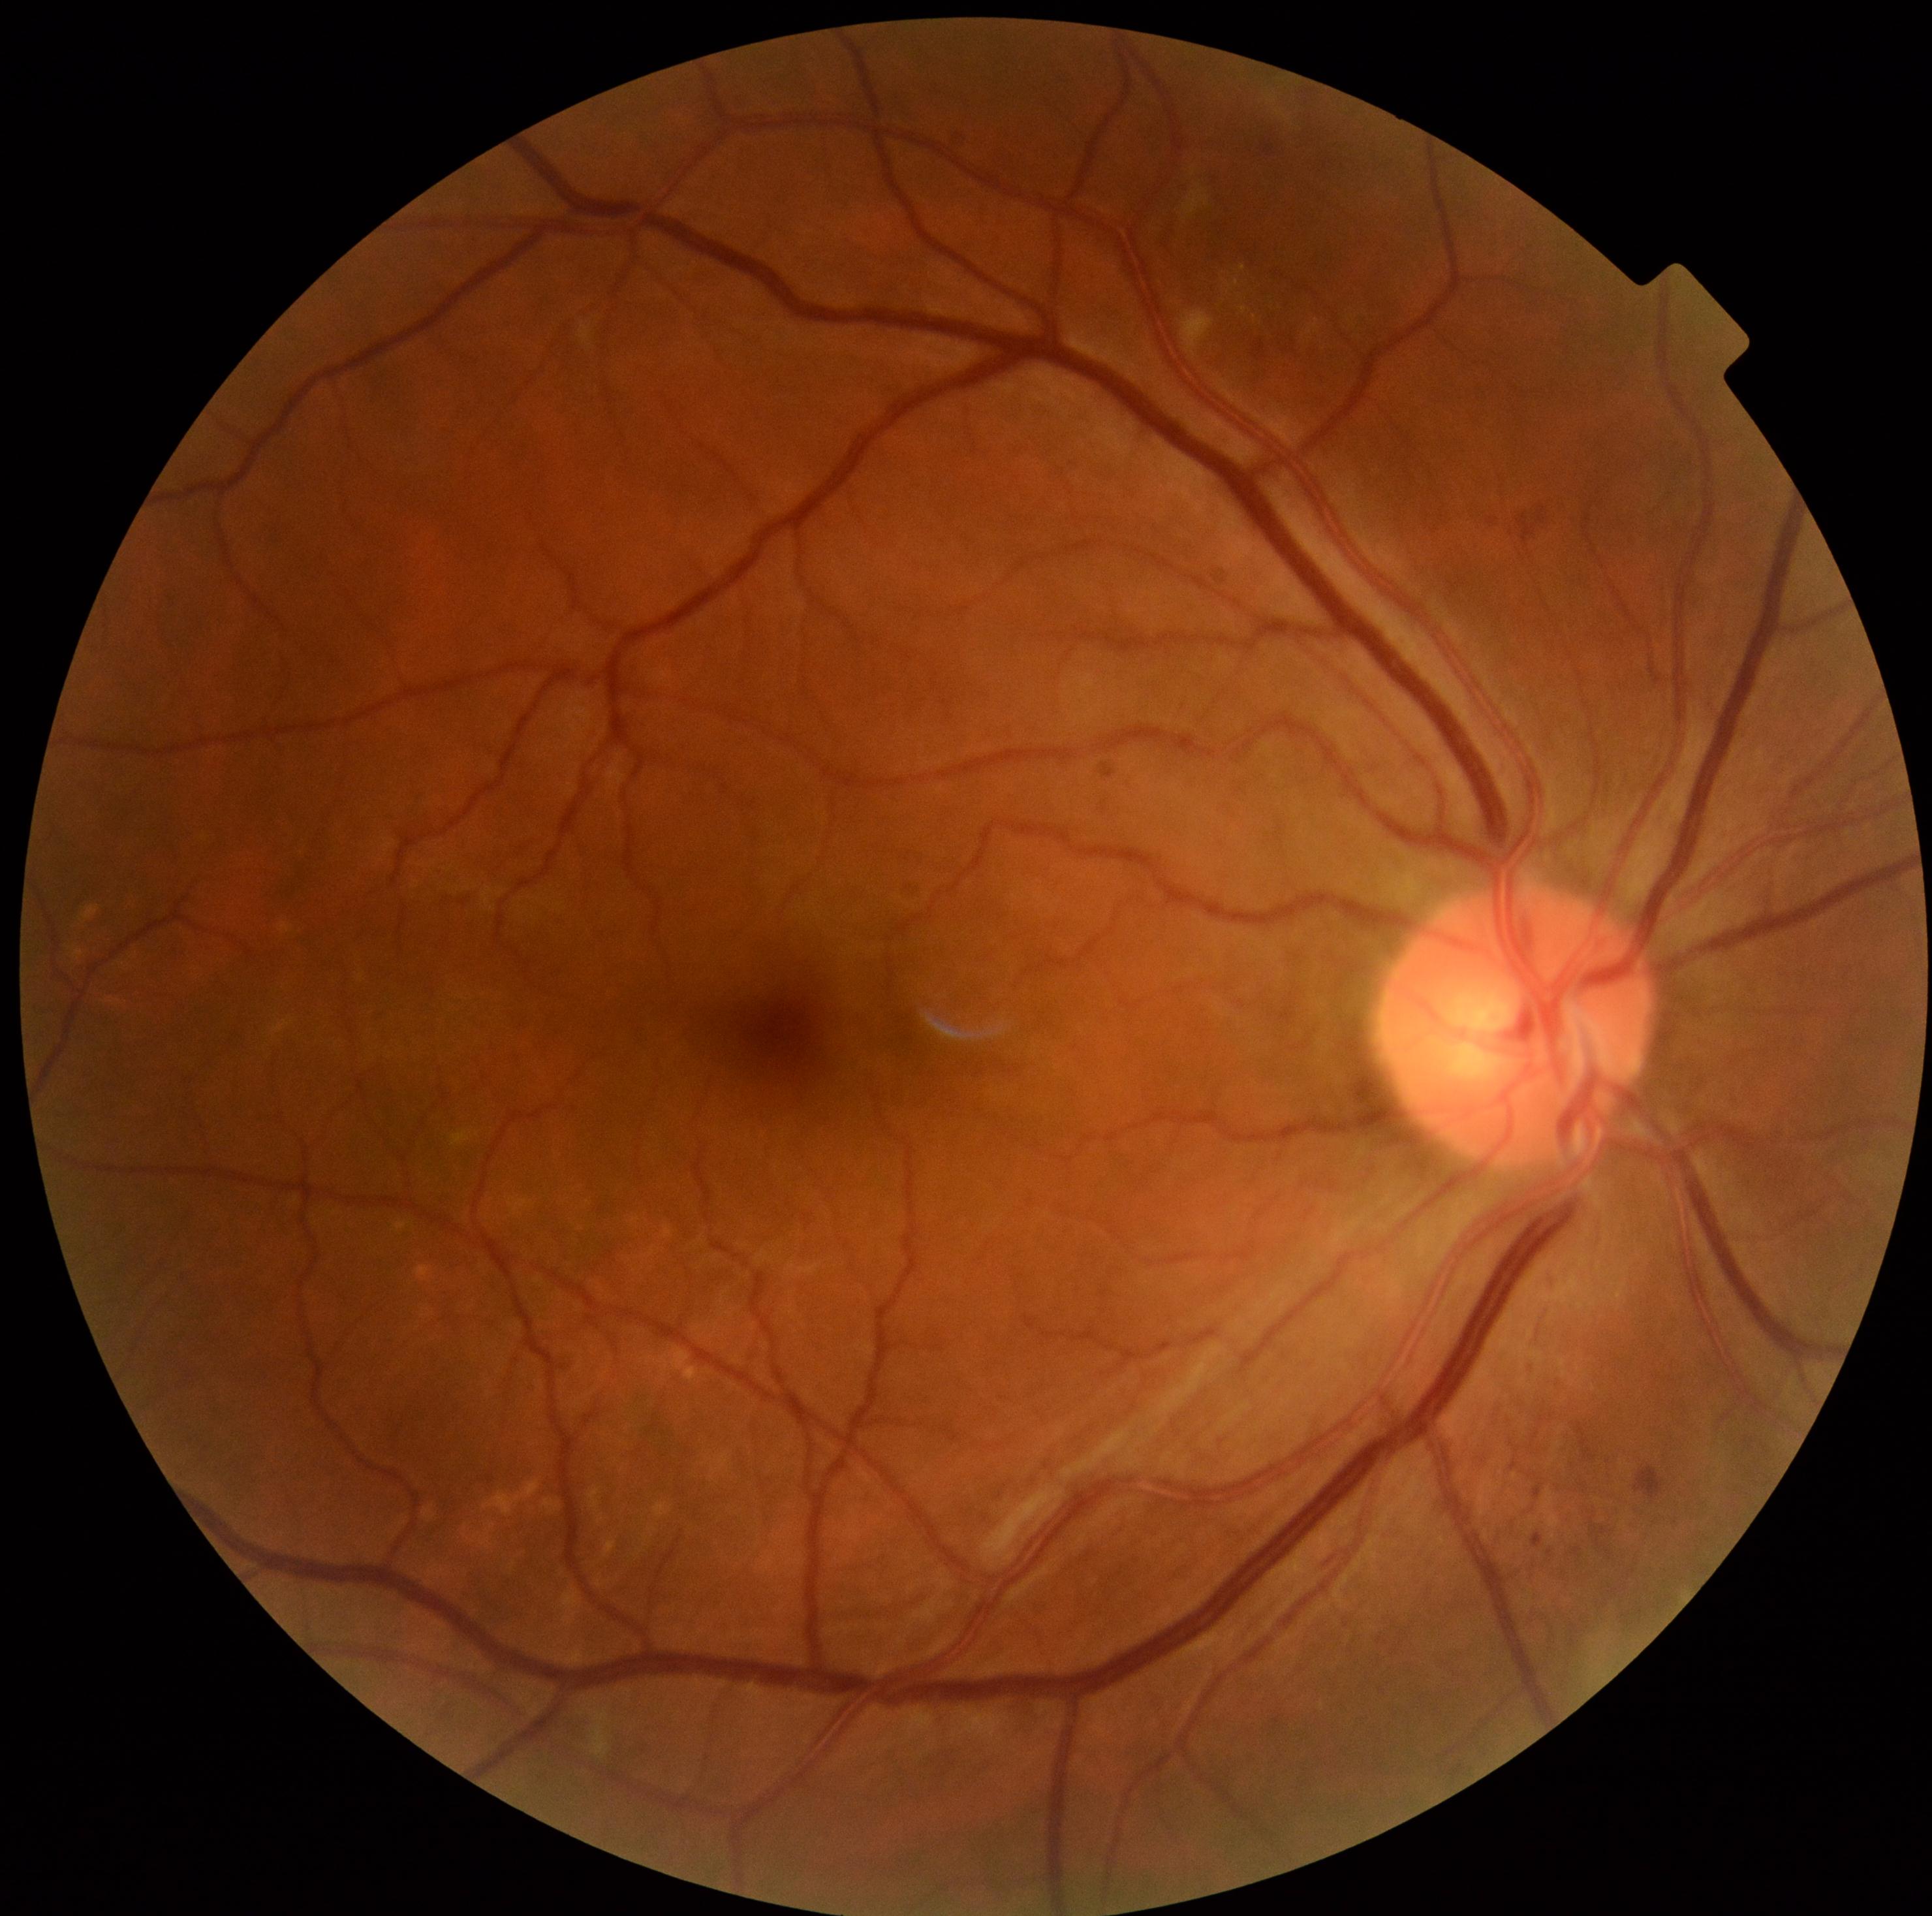

diabetic retinopathy=grade 2 (moderate NPDR) — more than just microaneurysms but less than severe NPDR.